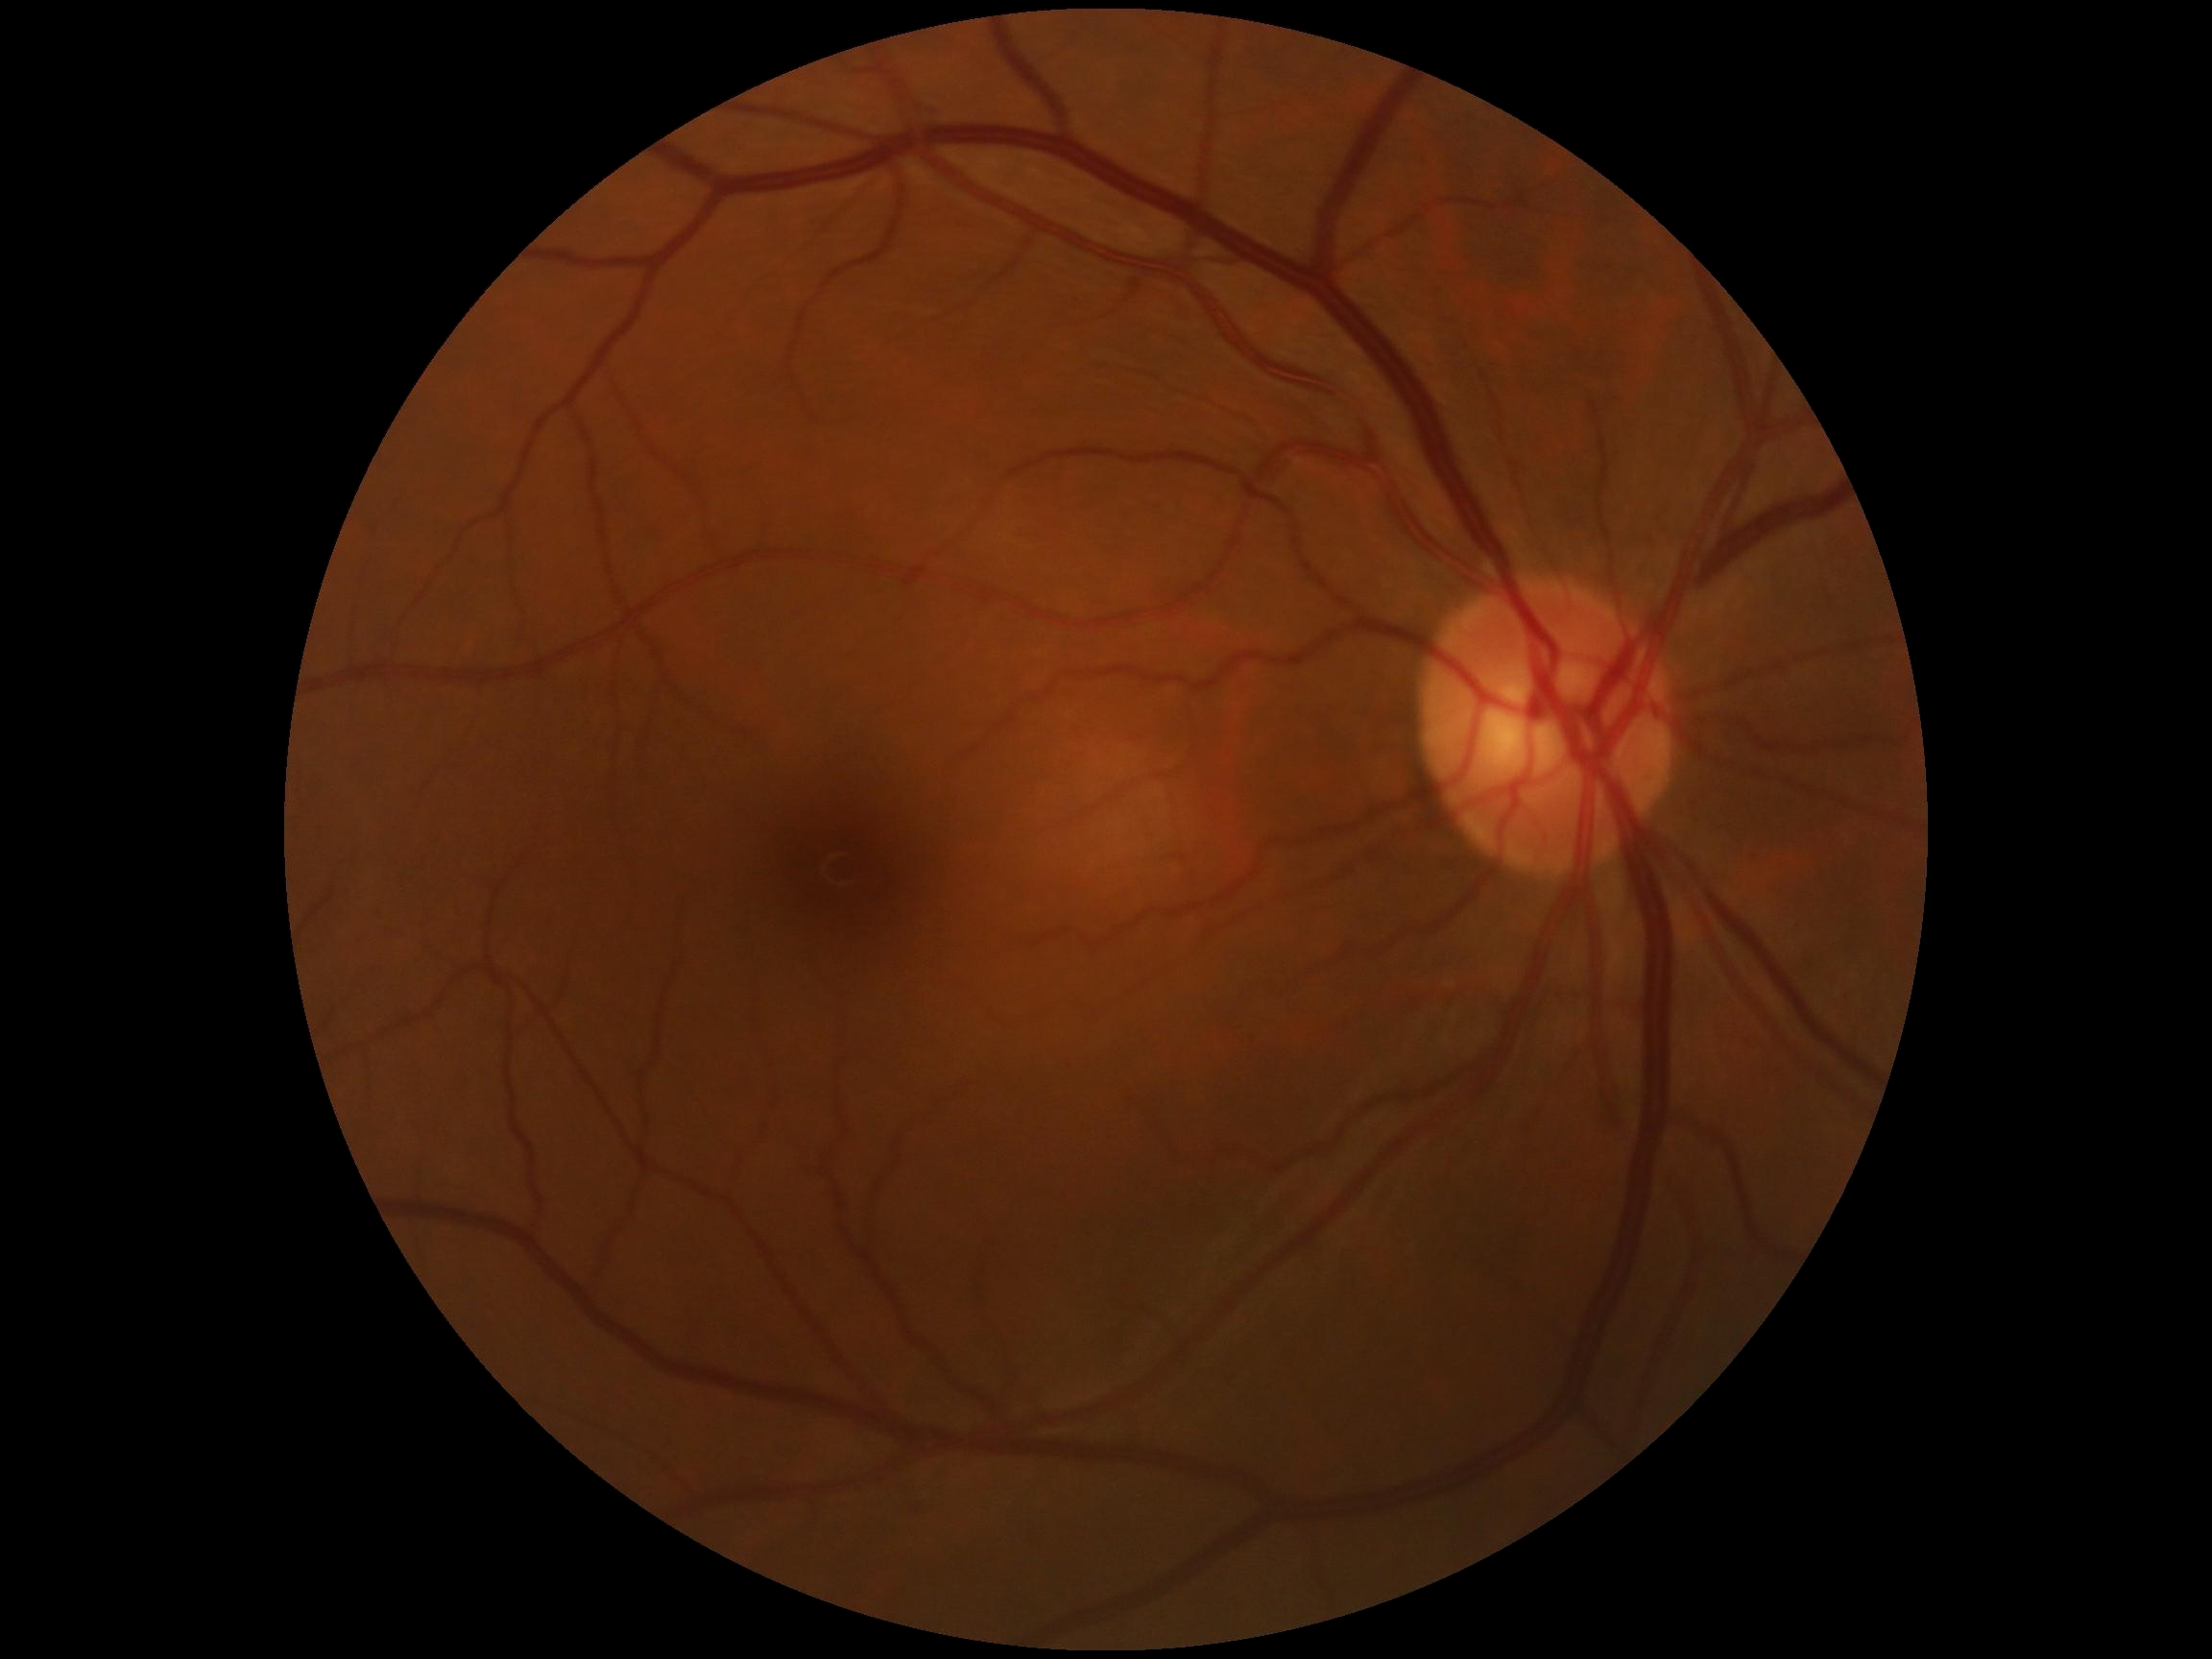

Diabetic retinopathy grade: no apparent retinopathy (0).